1440x1080. 130° field of view (Natus RetCam Envision). Pediatric retinal photograph (wide-field)
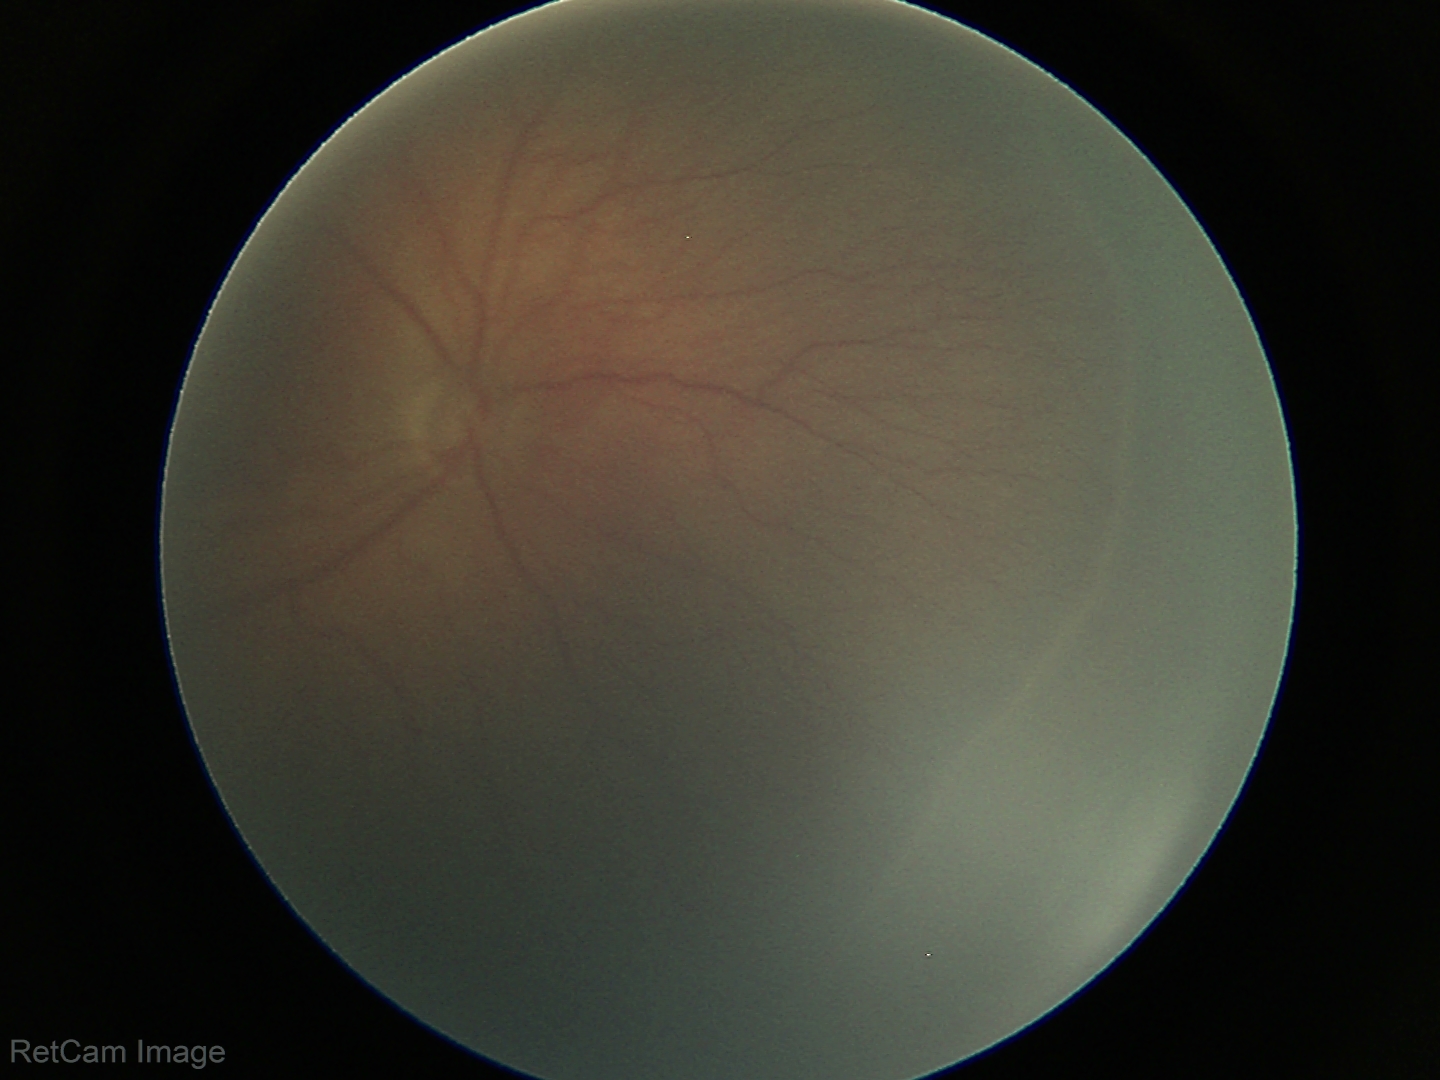
Impression: retinopathy of prematurity stage 3.